Infant wide-field fundus photograph: 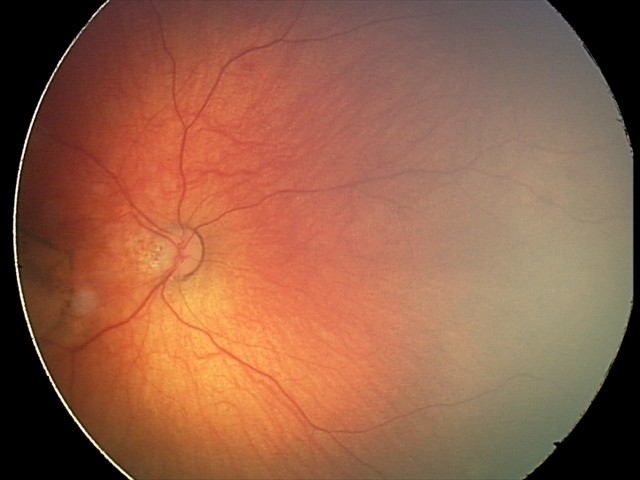
Examination diagnosed as toxoplasmosis chorioretinitis.